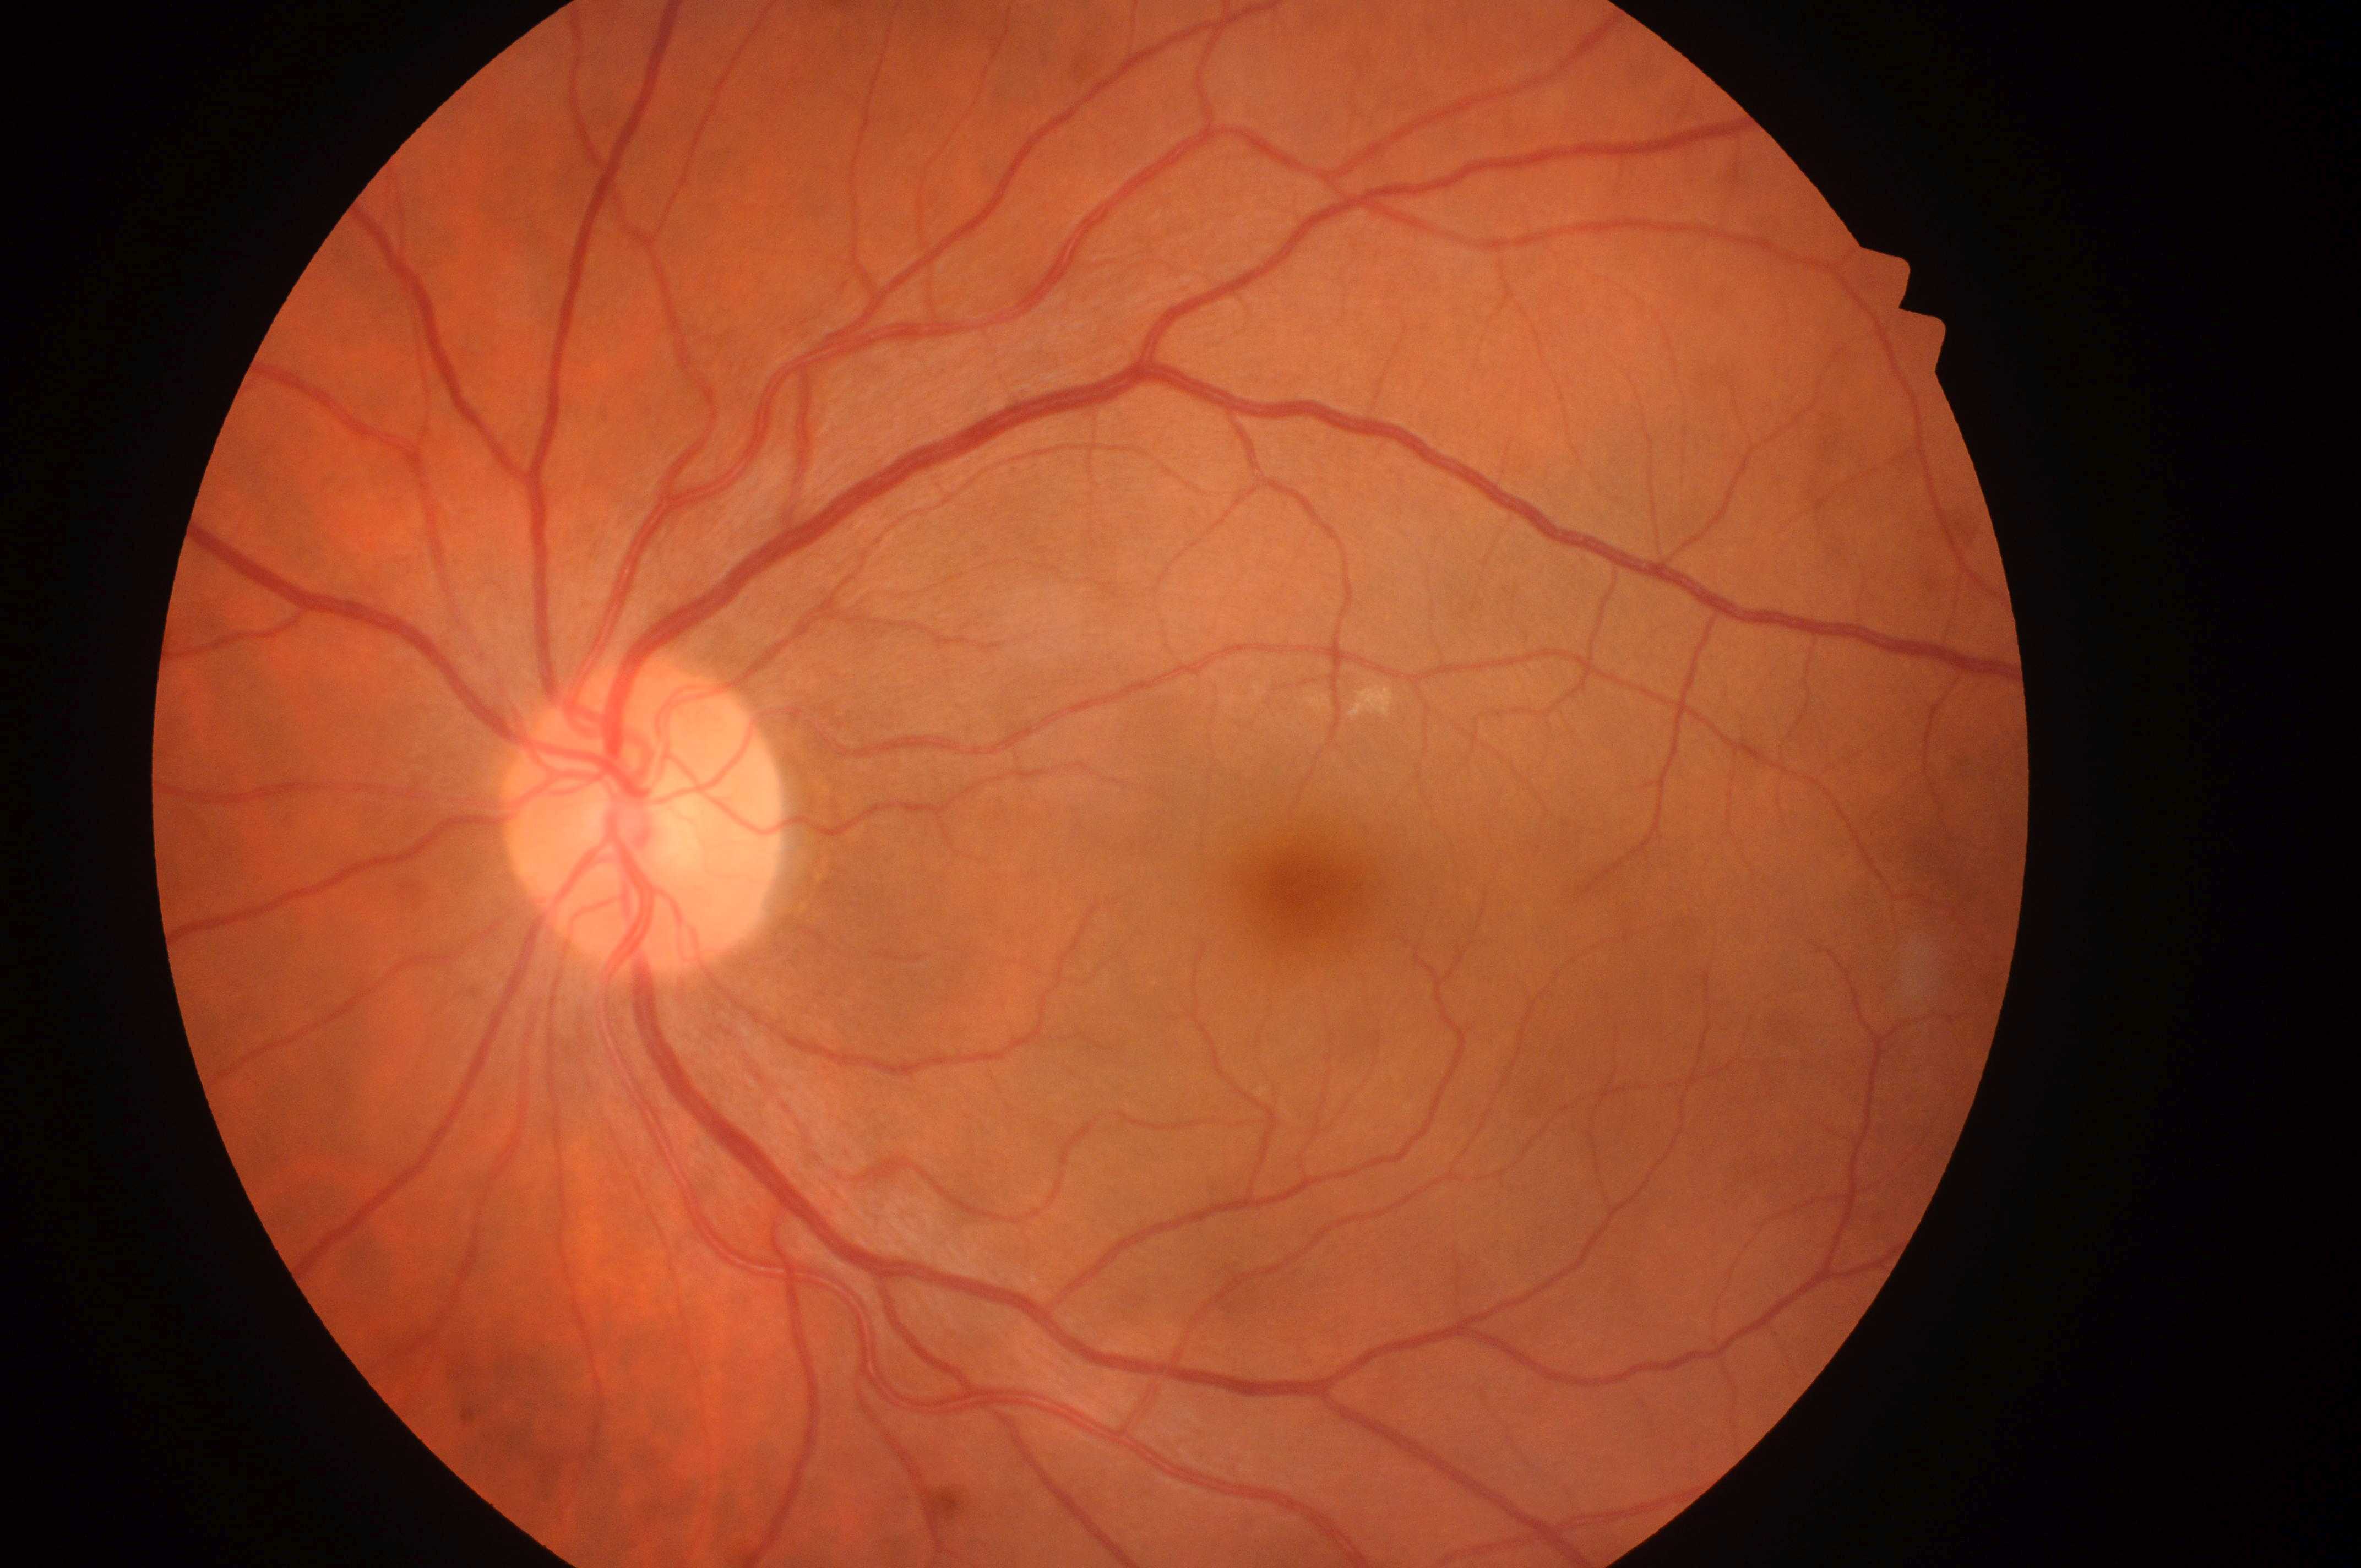
Q: Locate the optic disc.
A: (x: 639, y: 829)
Q: What is the DR grade?
A: grade 0 (no apparent retinopathy)
Q: What is the laterality?
A: left
Q: DR/DME impression?
A: No diabetic retinopathy; no macular edema risk
Q: What is the DME risk grade?
A: no risk (0)
Q: Fovea center?
A: (x: 1310, y: 897)